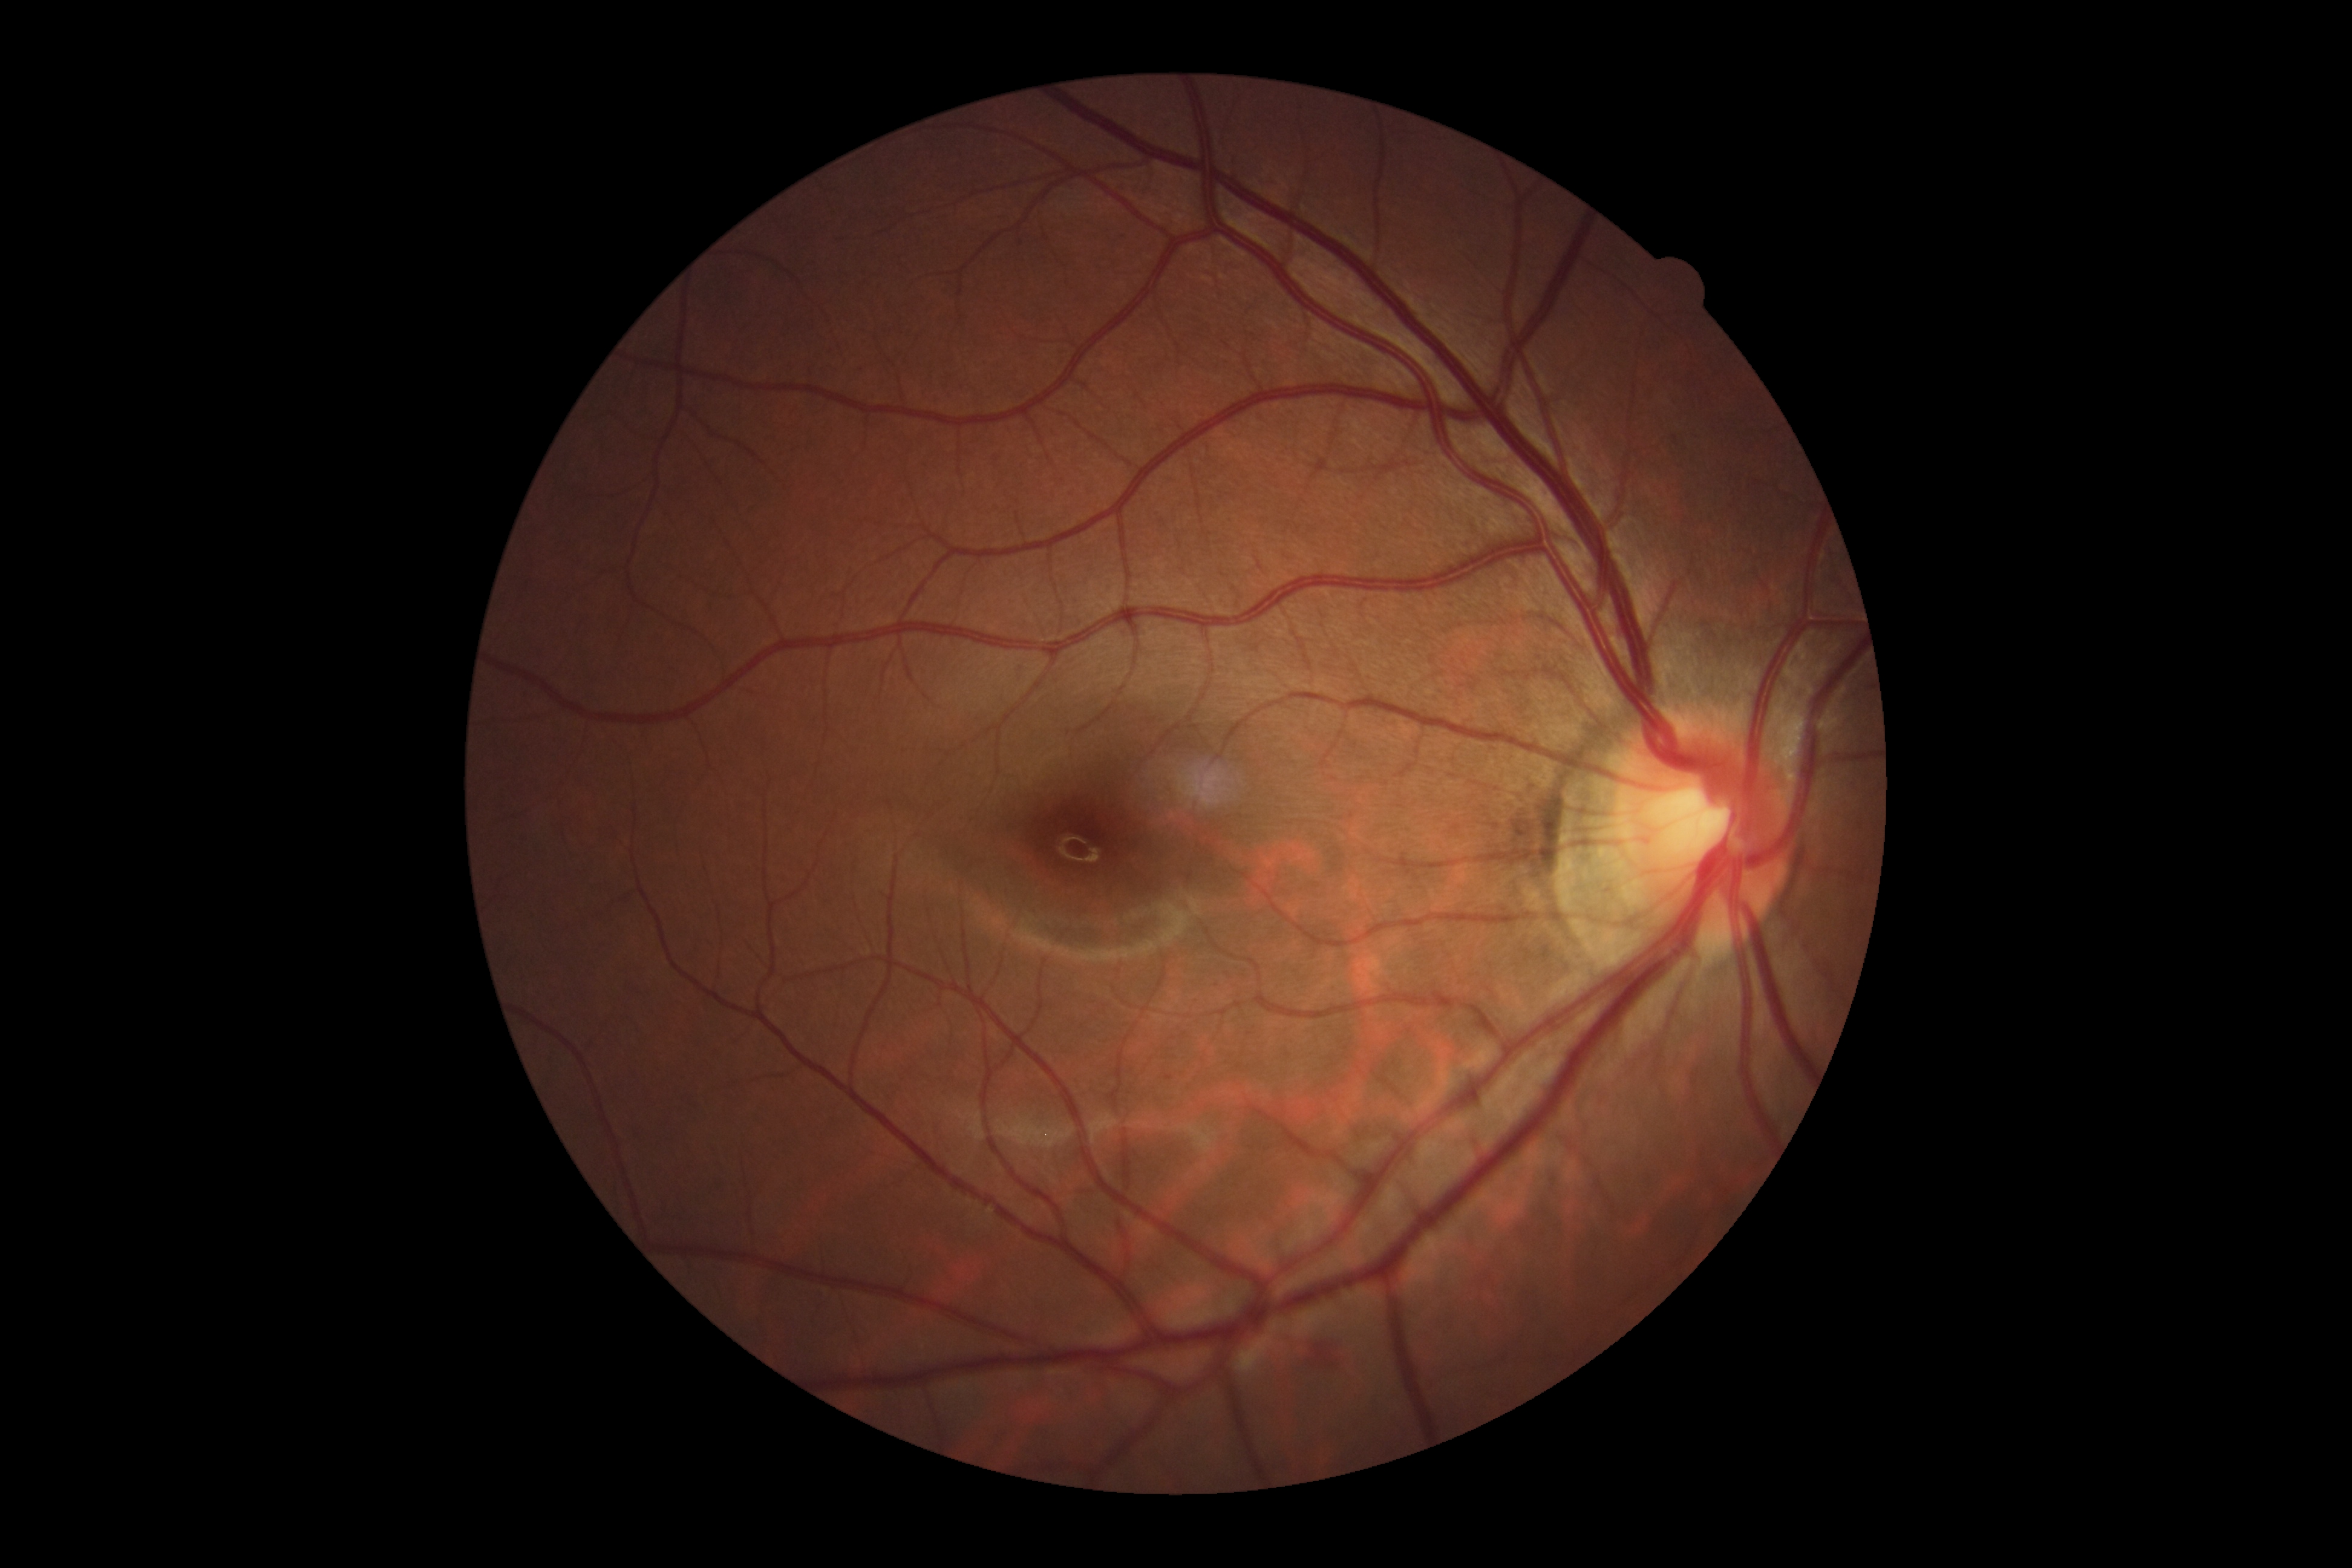 No diabetic retinal disease findings.
DR severity: no apparent retinopathy (grade 0).